Image size 2212x1659:
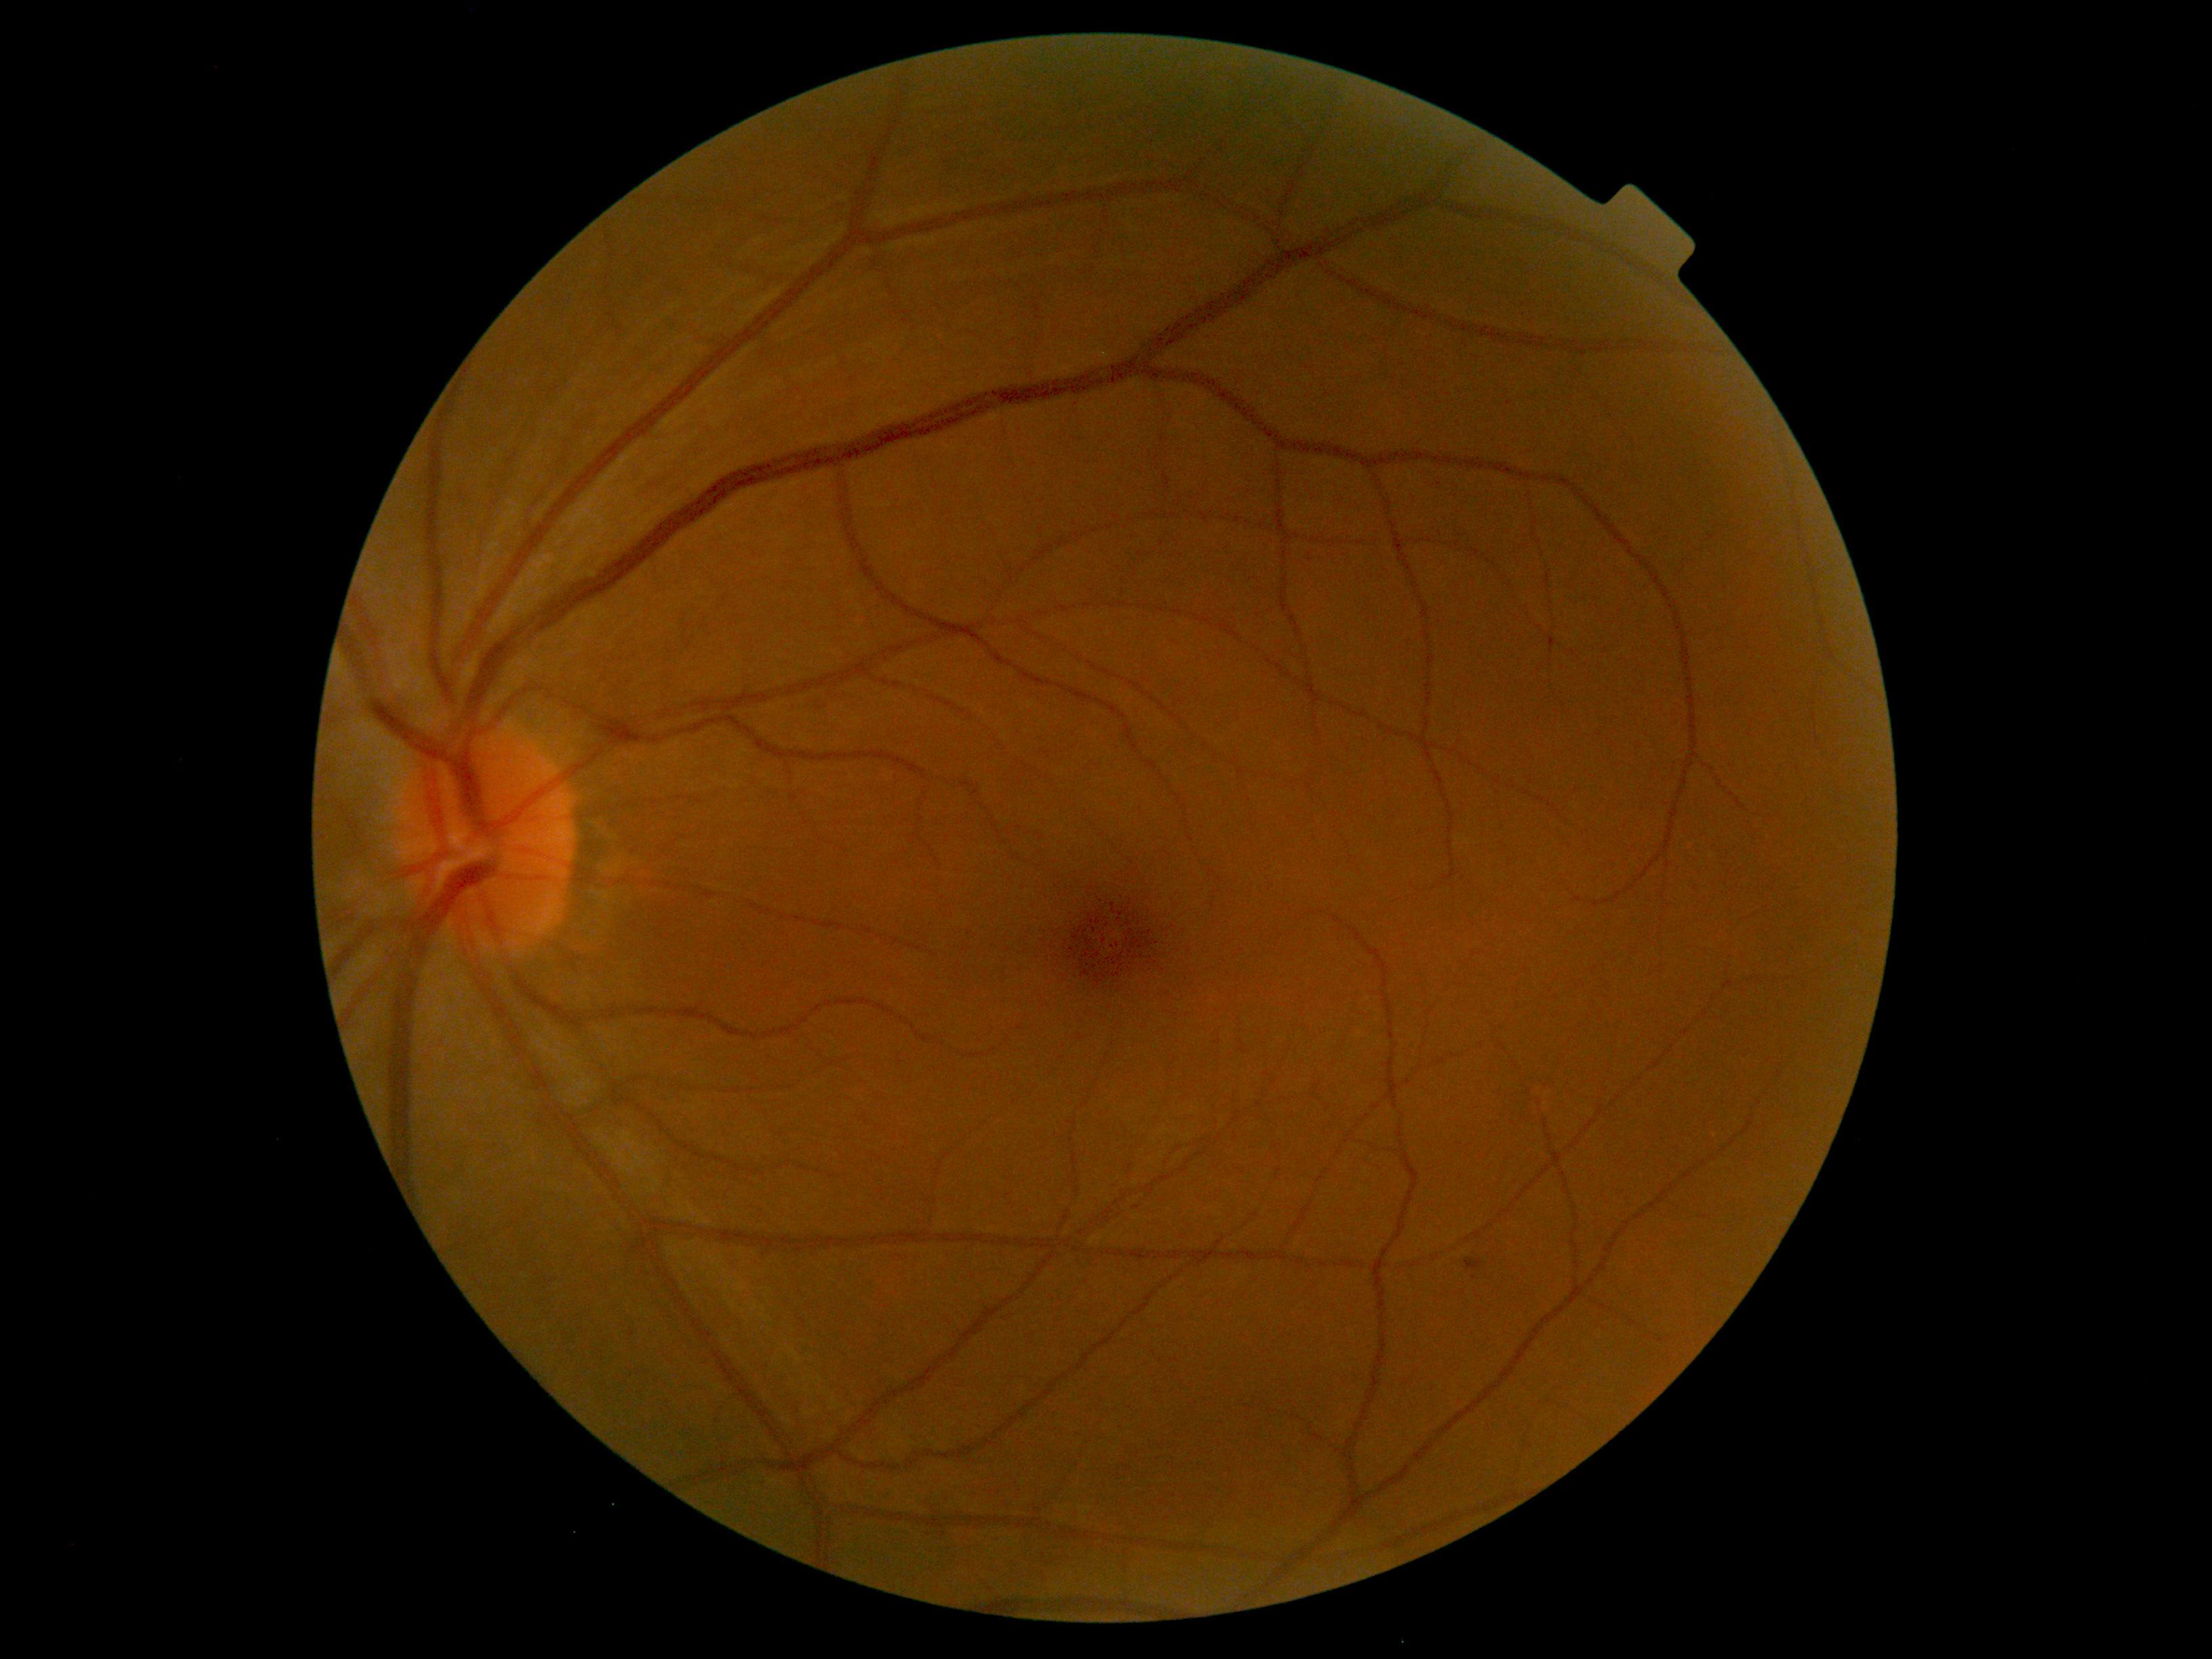 Diabetic retinopathy: grade 1.